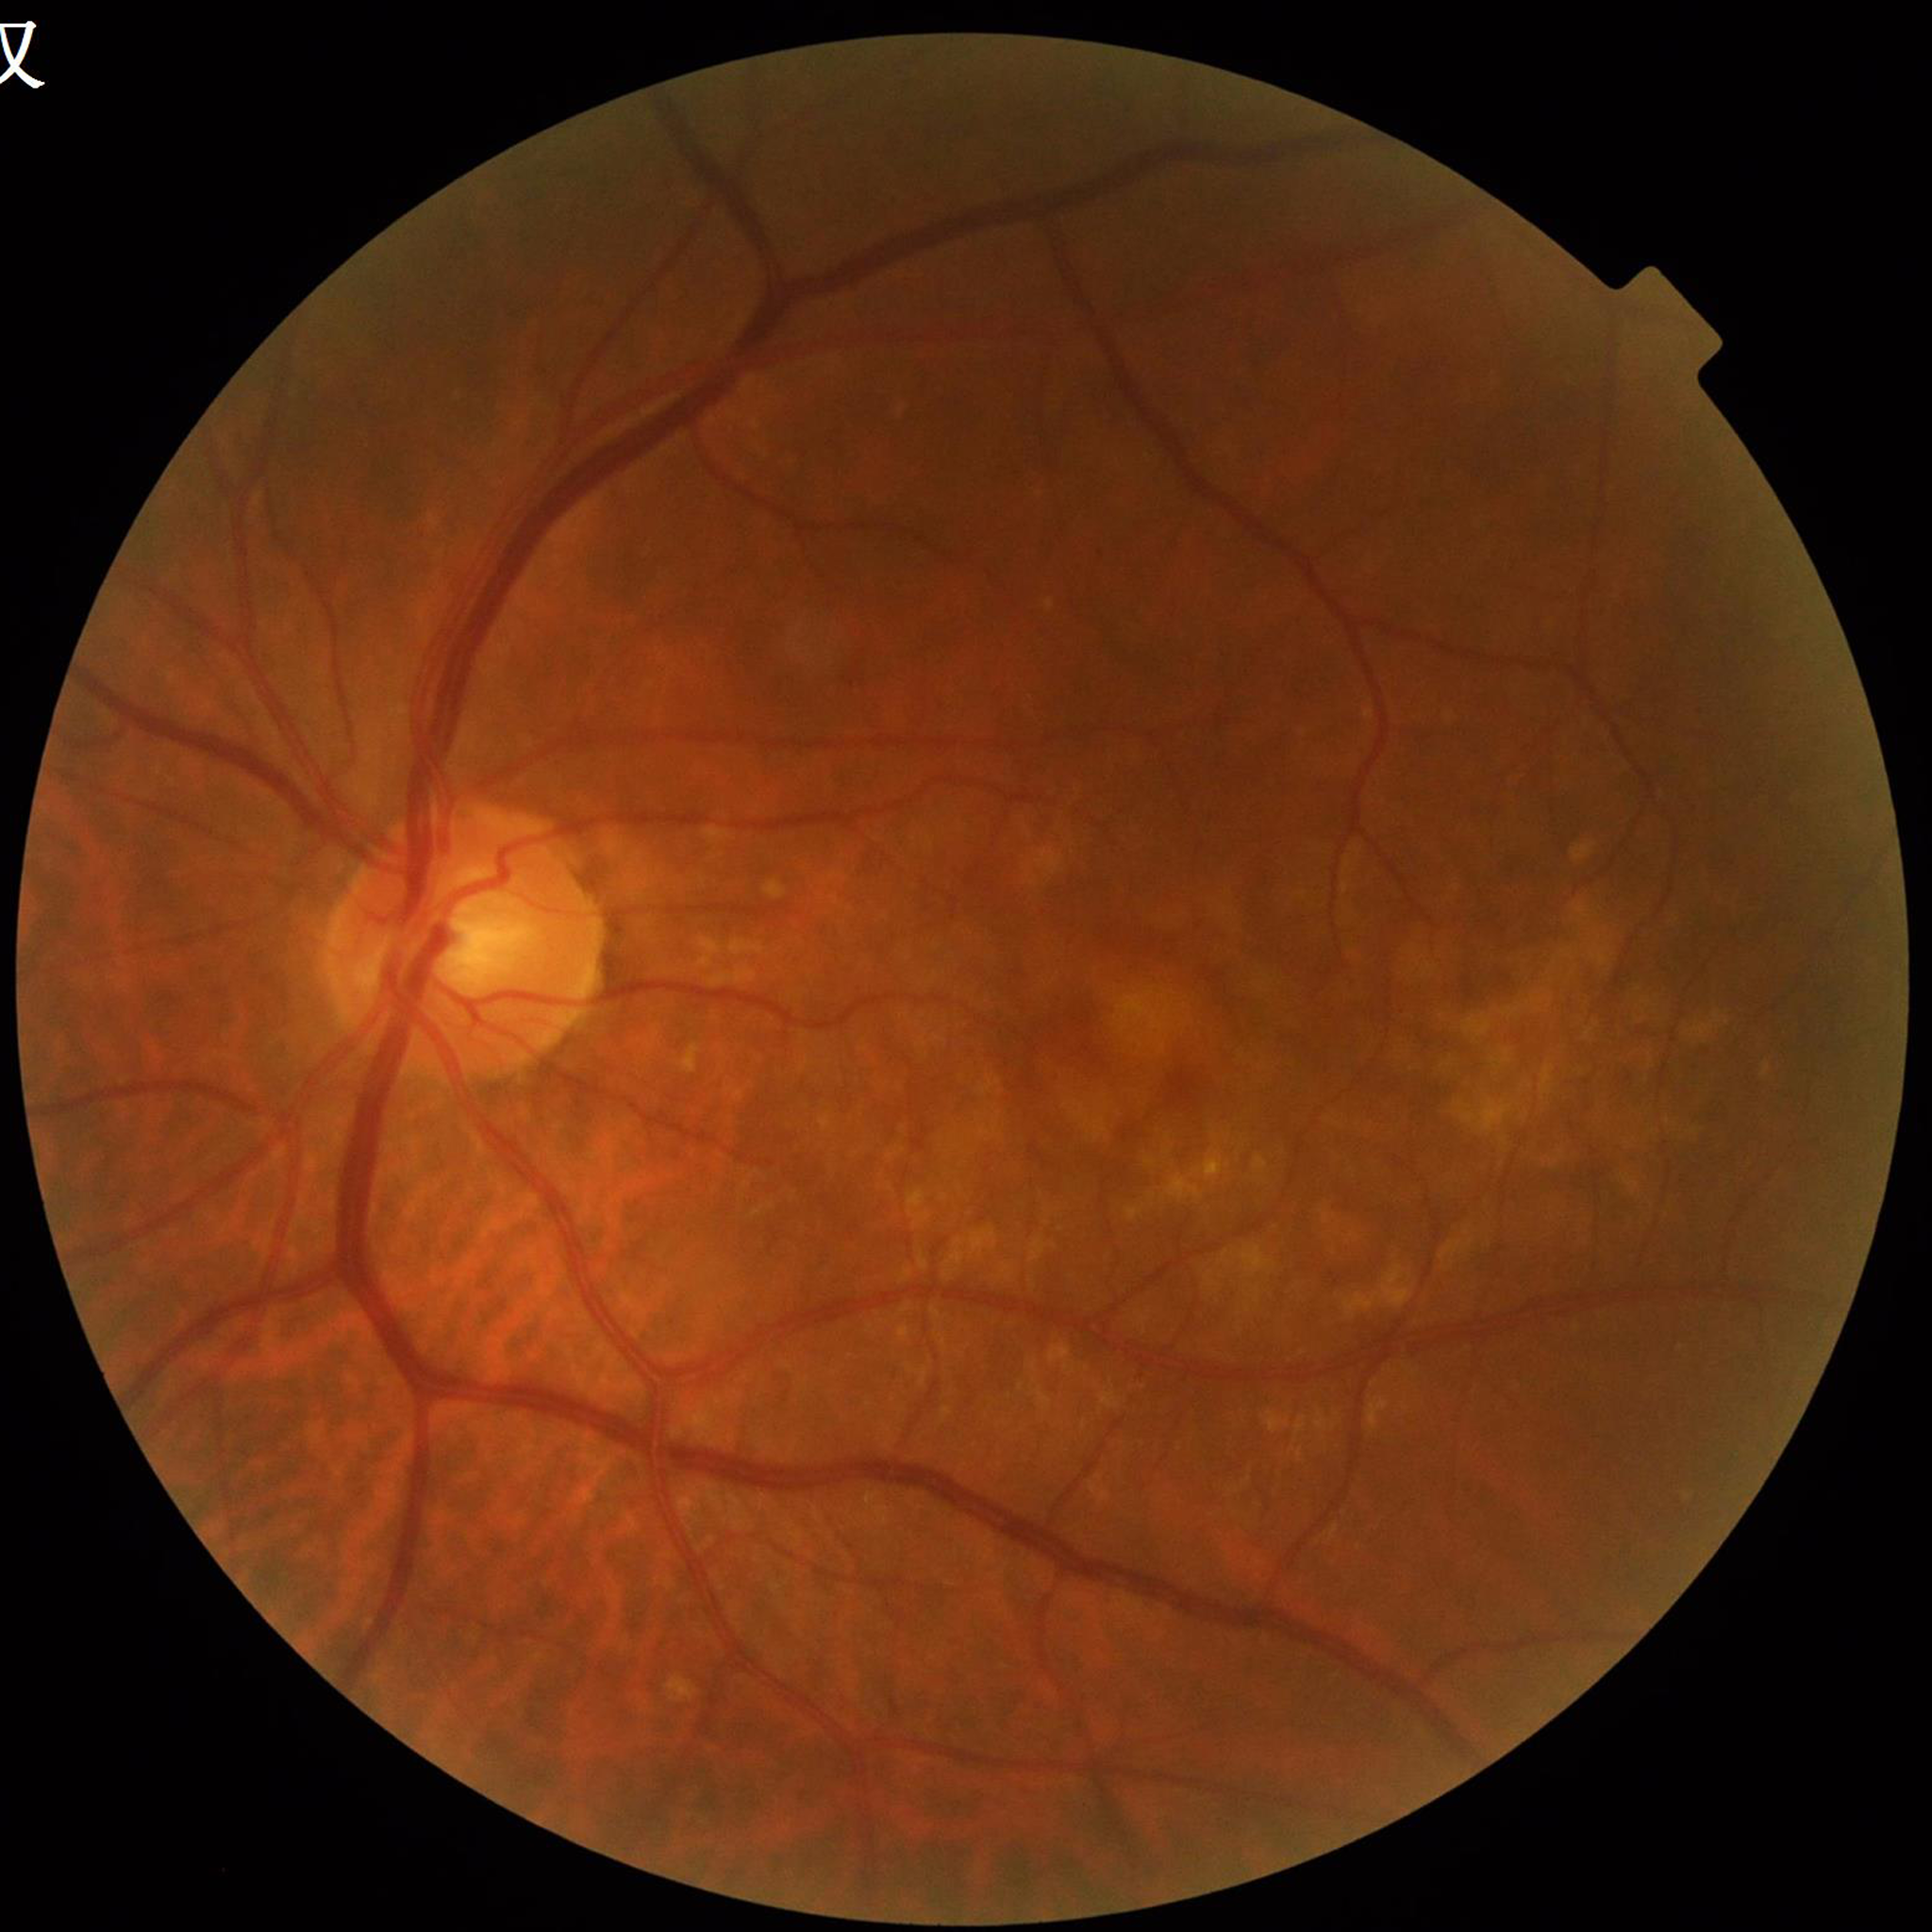

Disease = age-related macular degeneration (AMD)
Quality = adequate